Camera: Bosch fundus camera · 1920x1440 · fundus photo:
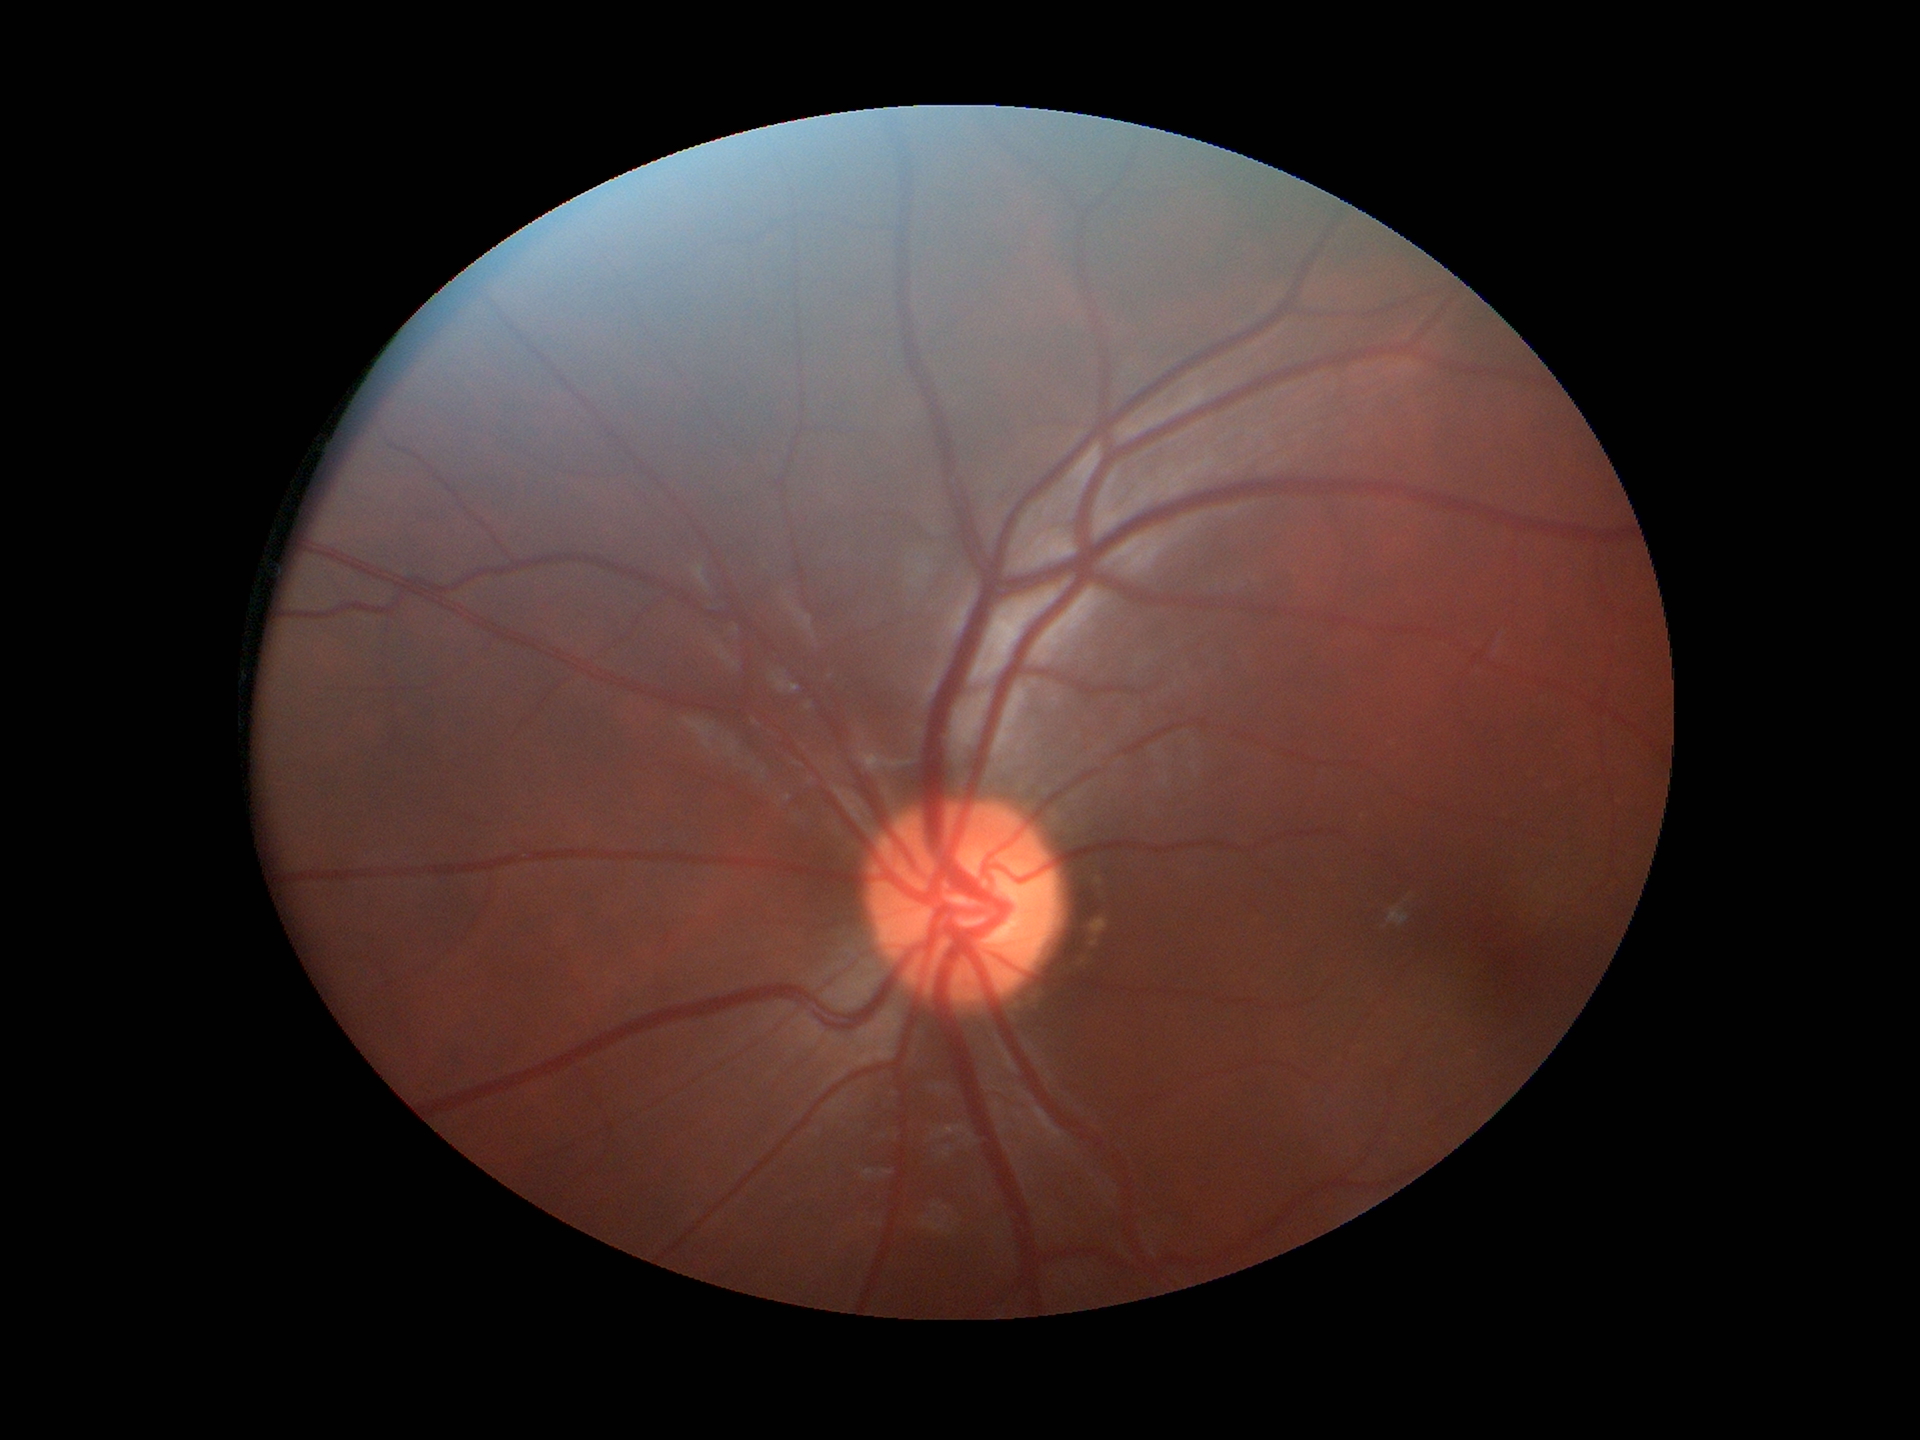
Q: What is the VCDR?
A: 0.50
Q: Glaucoma screening result?
A: not suspect (one of five ophthalmologists flagged glaucoma suspect)